No pharmacologic dilation: 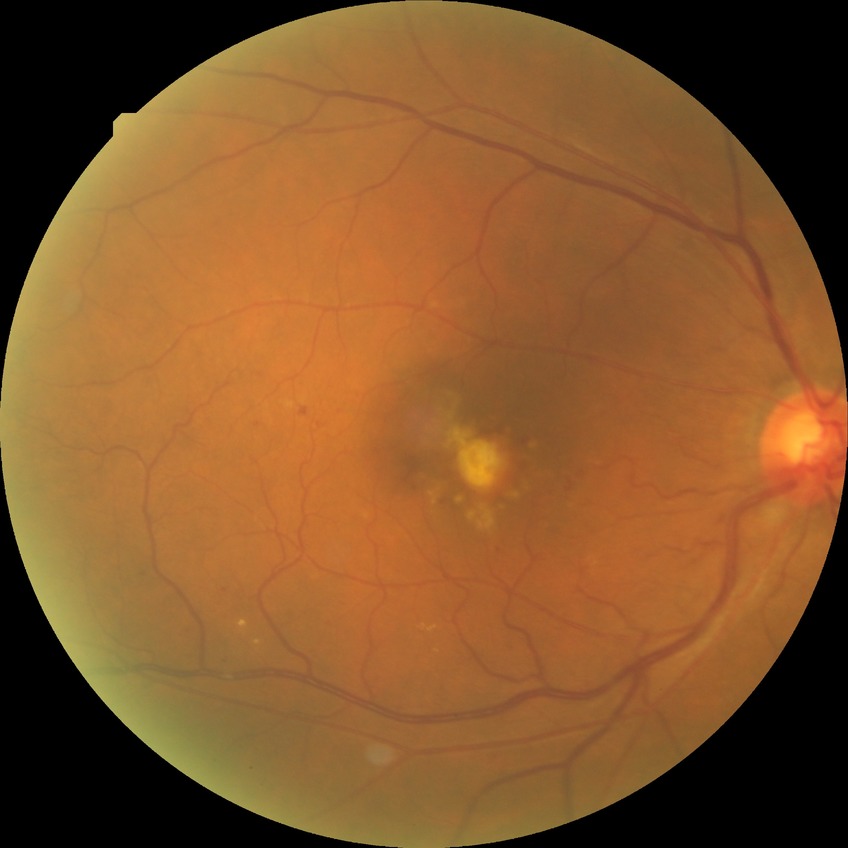 Diabetic retinopathy severity is no diabetic retinopathy.